Camera: NIDEK AFC-230: 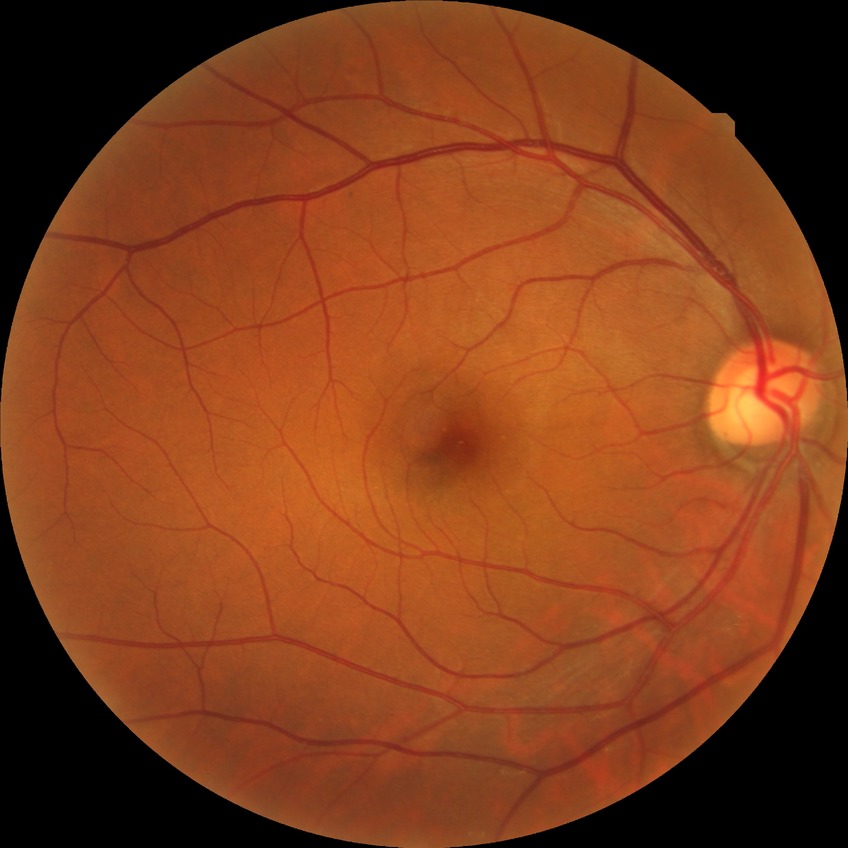
Diabetic retinopathy (DR) is no diabetic retinopathy (NDR).